1440 x 1080 pixels · wide-field fundus photograph from neonatal ROP screening.
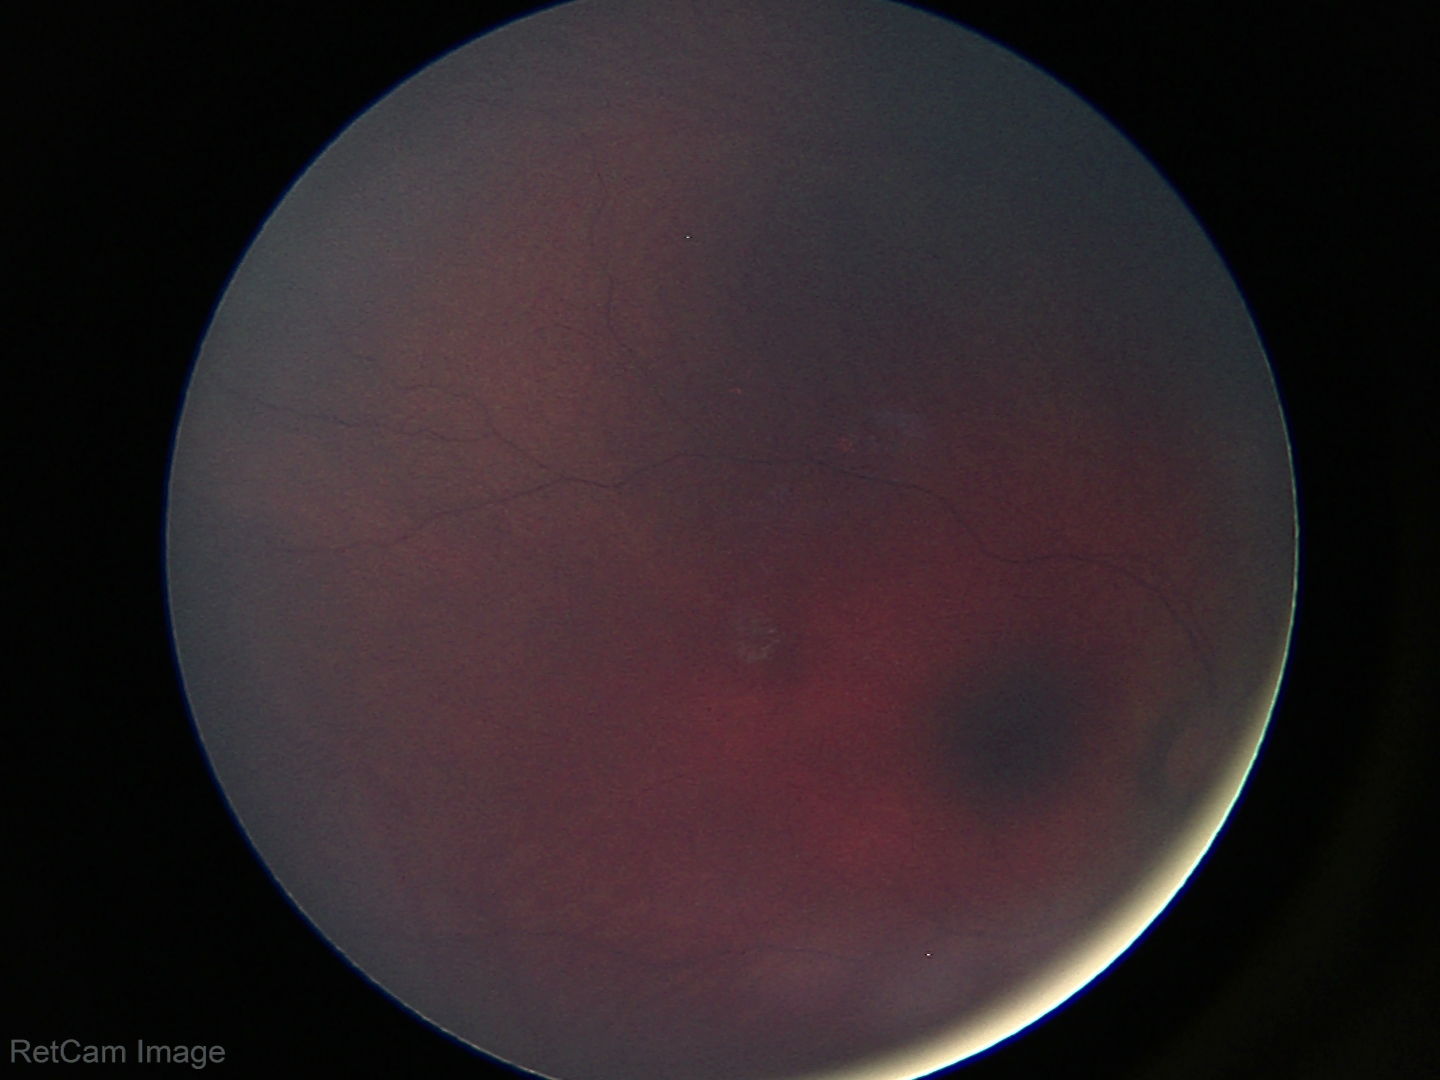
Screening examination diagnosed as physiological.